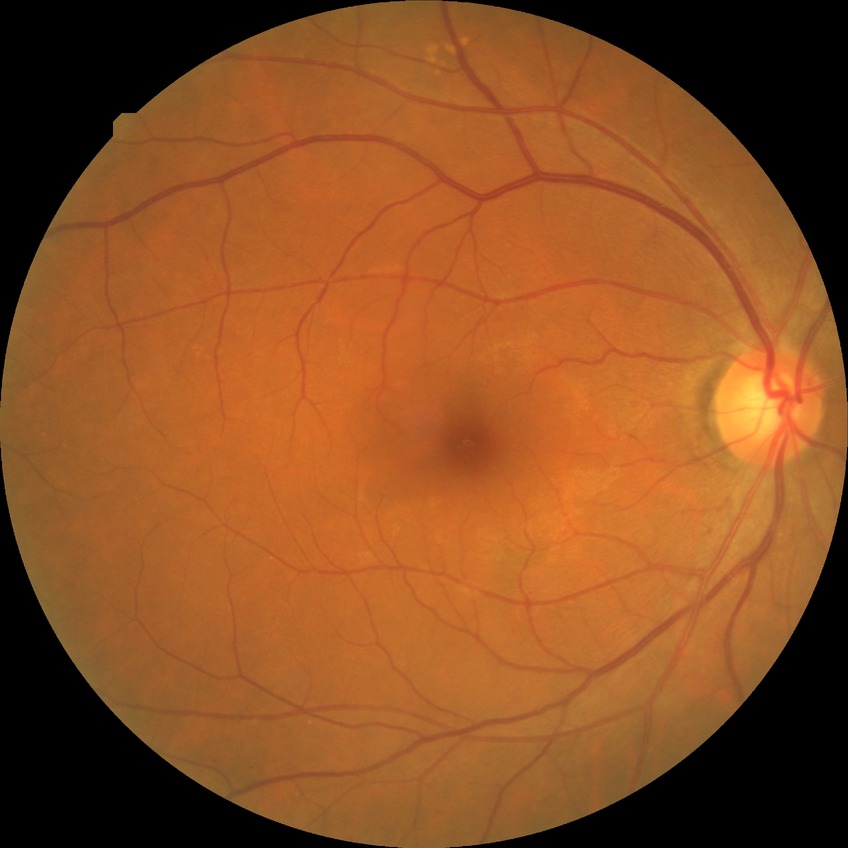

Diabetic retinopathy (DR) is no diabetic retinopathy (NDR).